1440 by 1080 pixels · pediatric retinal photograph (wide-field) · 130° field of view (Natus RetCam Envision): 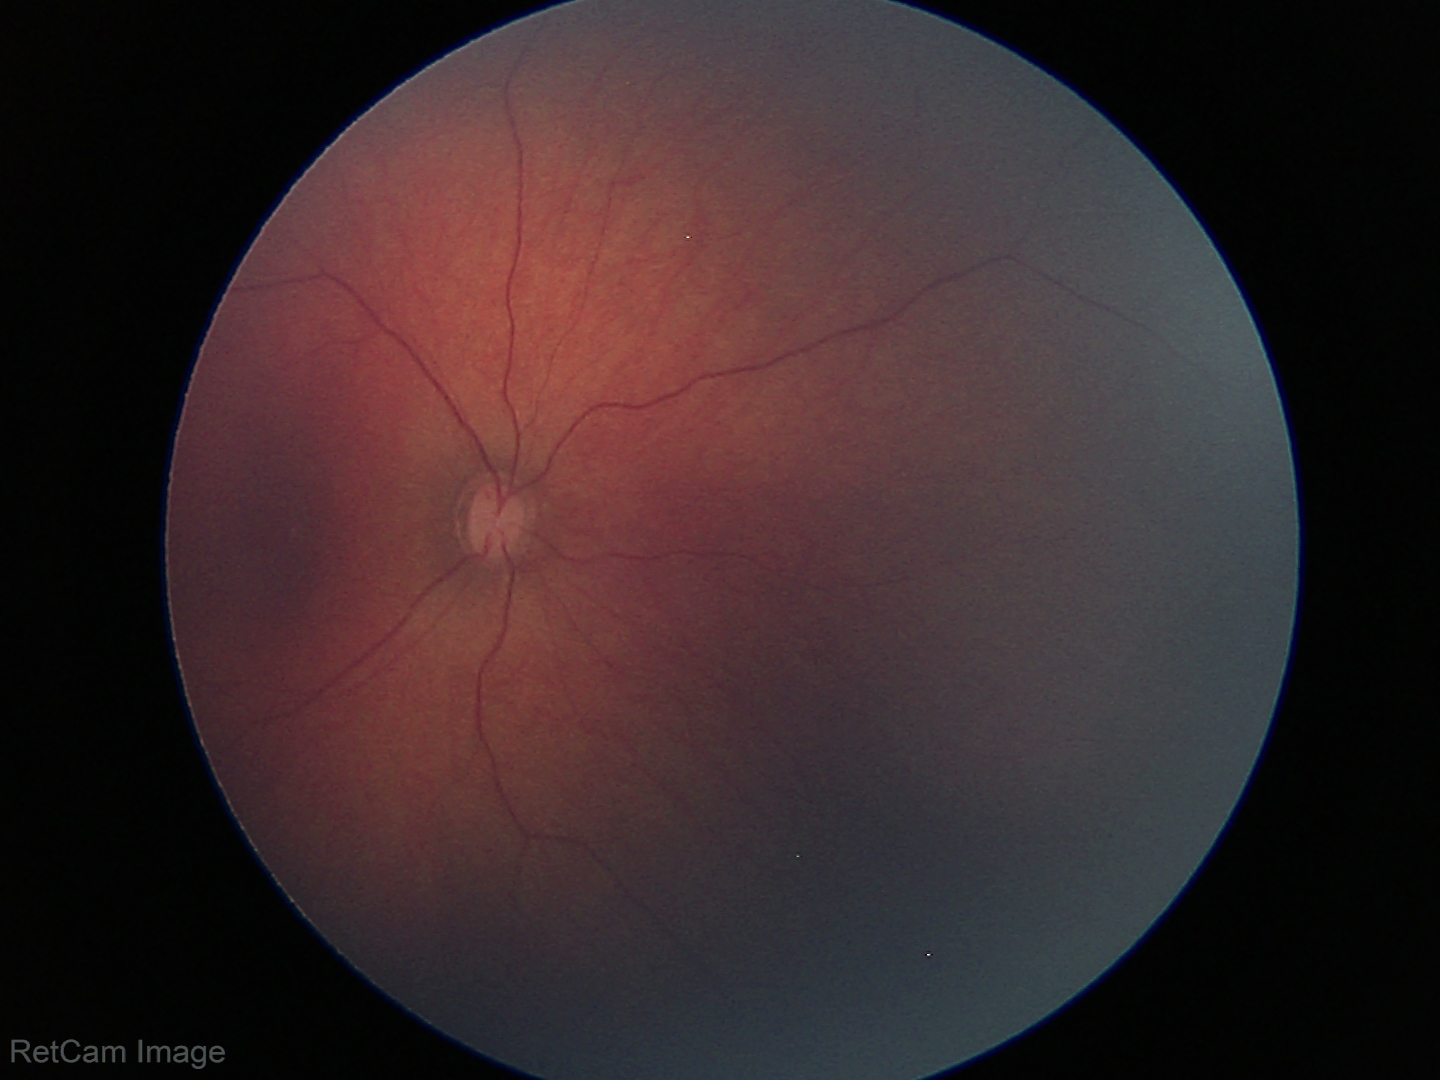 Physiological retinal appearance for postconceptual age.